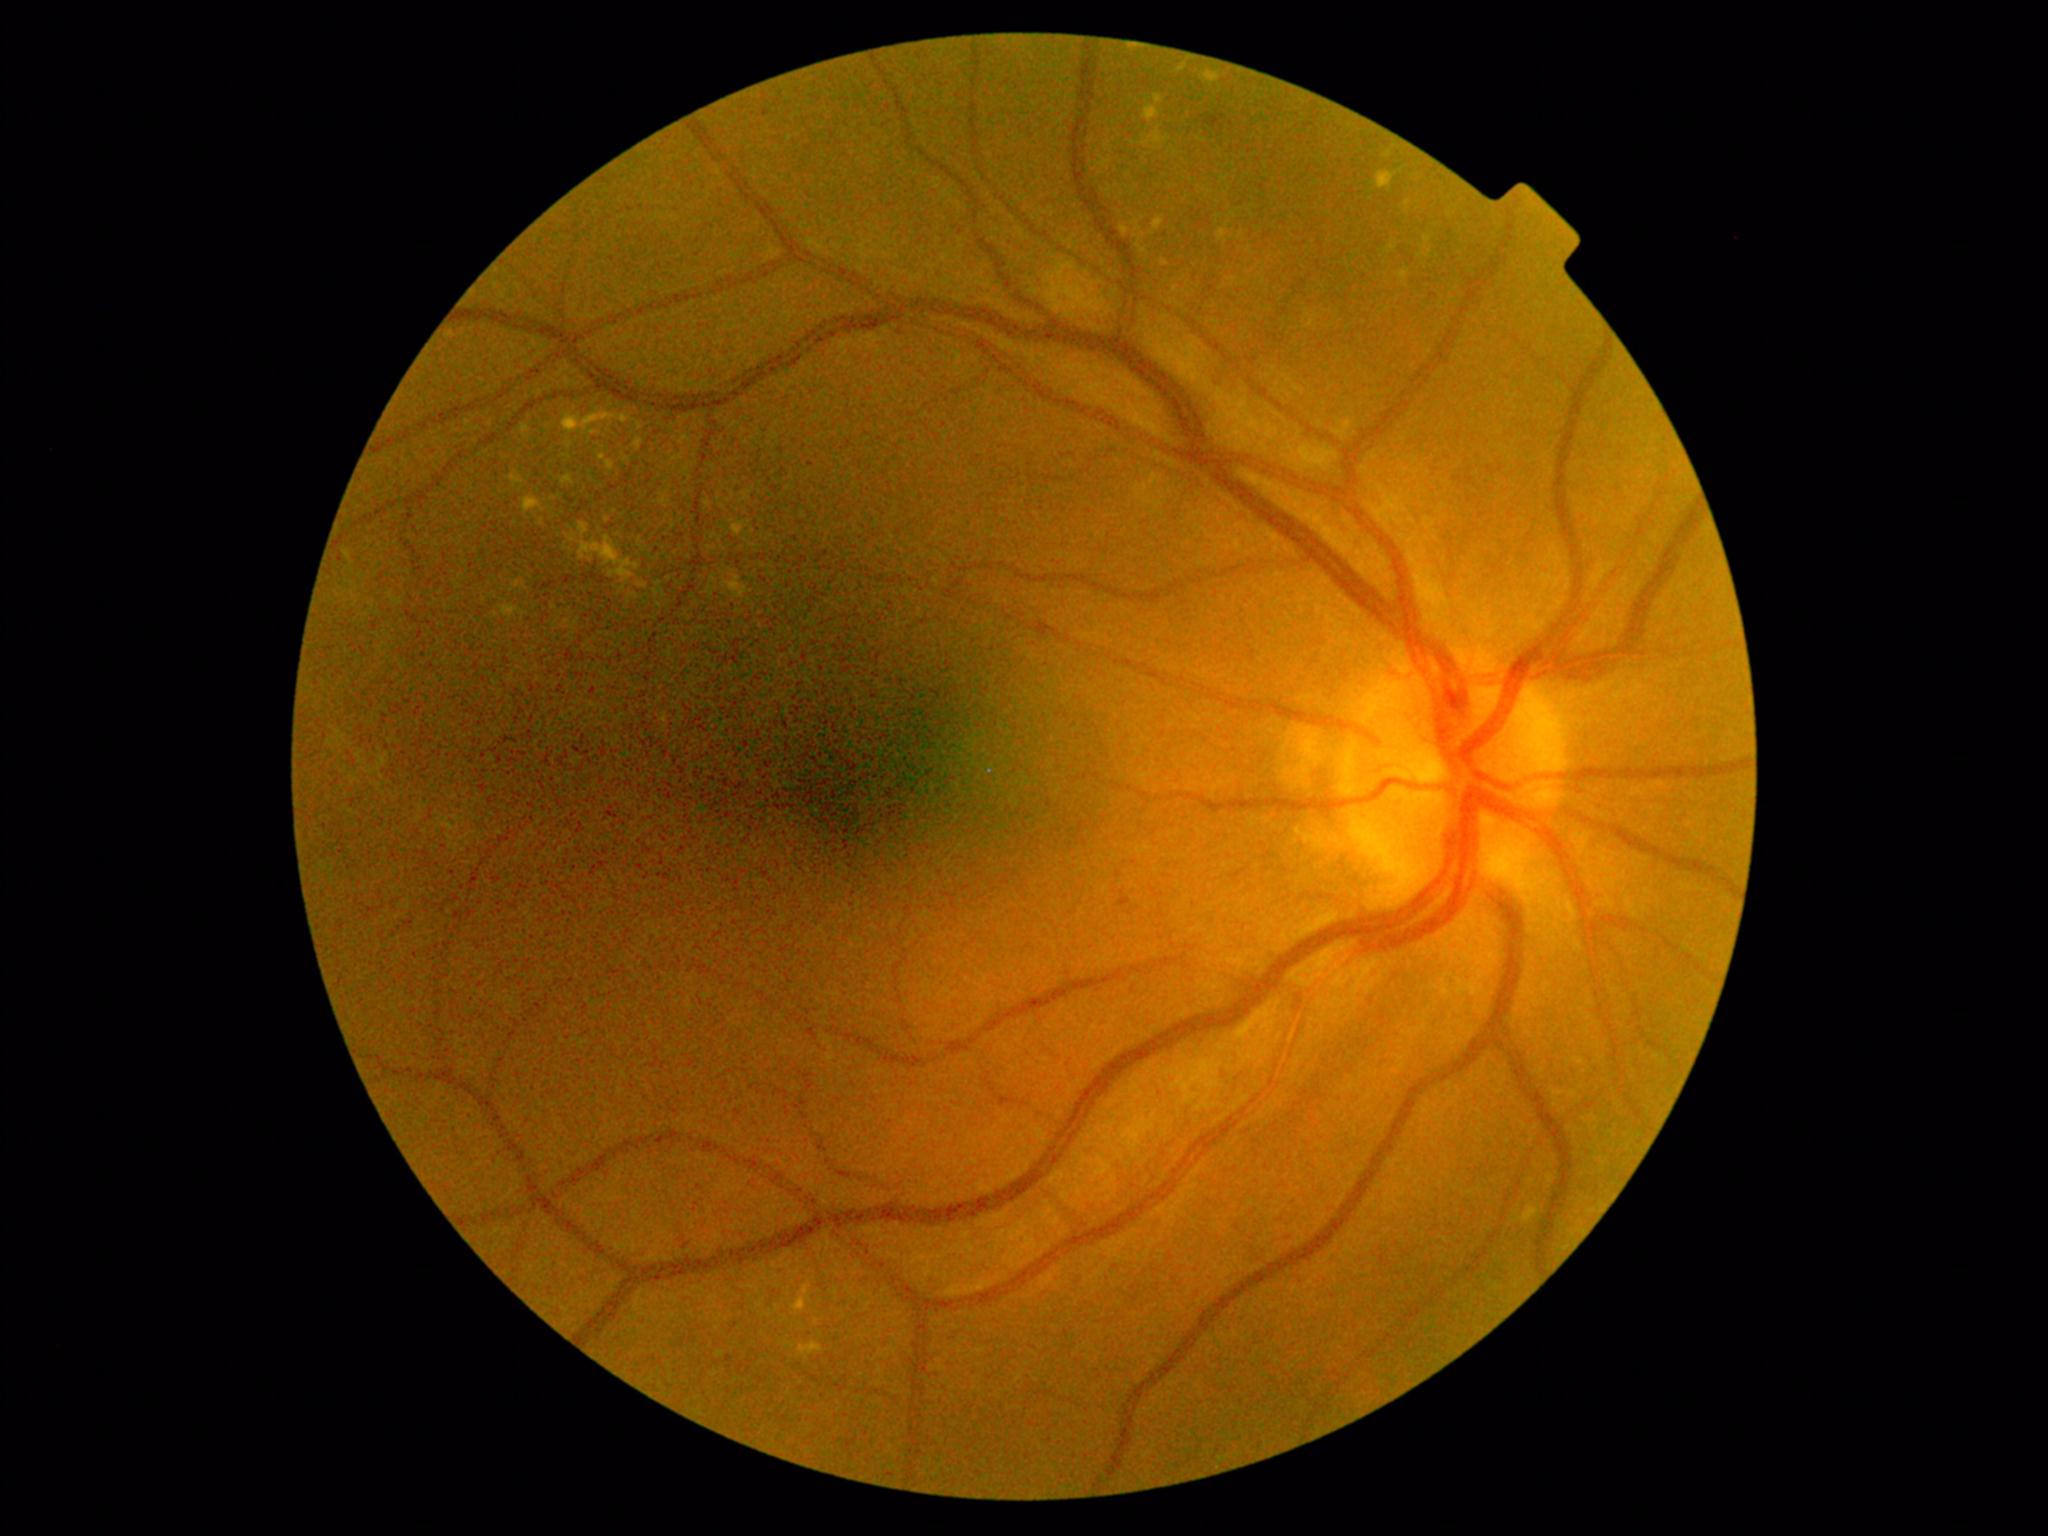

Retinopathy: moderate NPDR (grade 2); non-proliferative diabetic retinopathy. Hard exudates (partial list) at 510, 581, 528, 592 | 562, 409, 642, 436 | 1515, 1204, 1541, 1224 | 508, 472, 525, 488 | 634, 437, 644, 452 | 598, 454, 615, 472 | 1160, 259, 1170, 267 | 1424, 235, 1433, 245 | 799, 1342, 823, 1359 | 1218, 229, 1228, 242. Hard exudates (small, approximate centers) near pt(1408, 204) | pt(614, 511) | pt(1431, 252) | pt(1176, 290).